Wide-field fundus image from infant ROP screening · 100° field of view (Phoenix ICON): 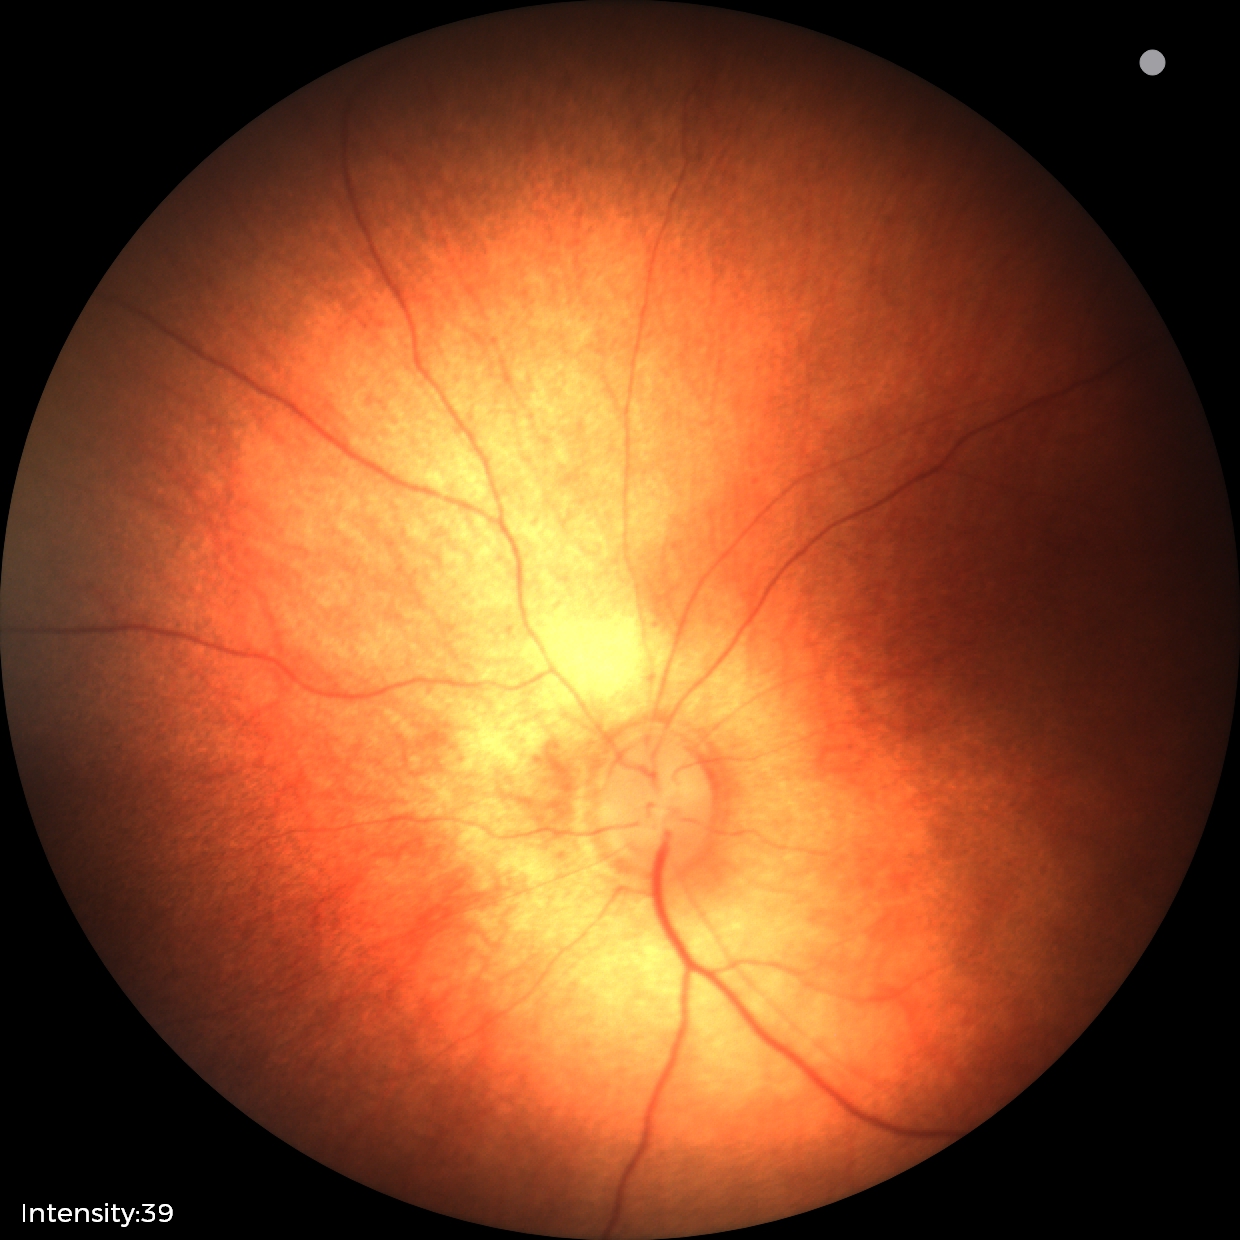 Q: What was the screening finding?
A: physiological finding